Infant wide-field fundus photograph
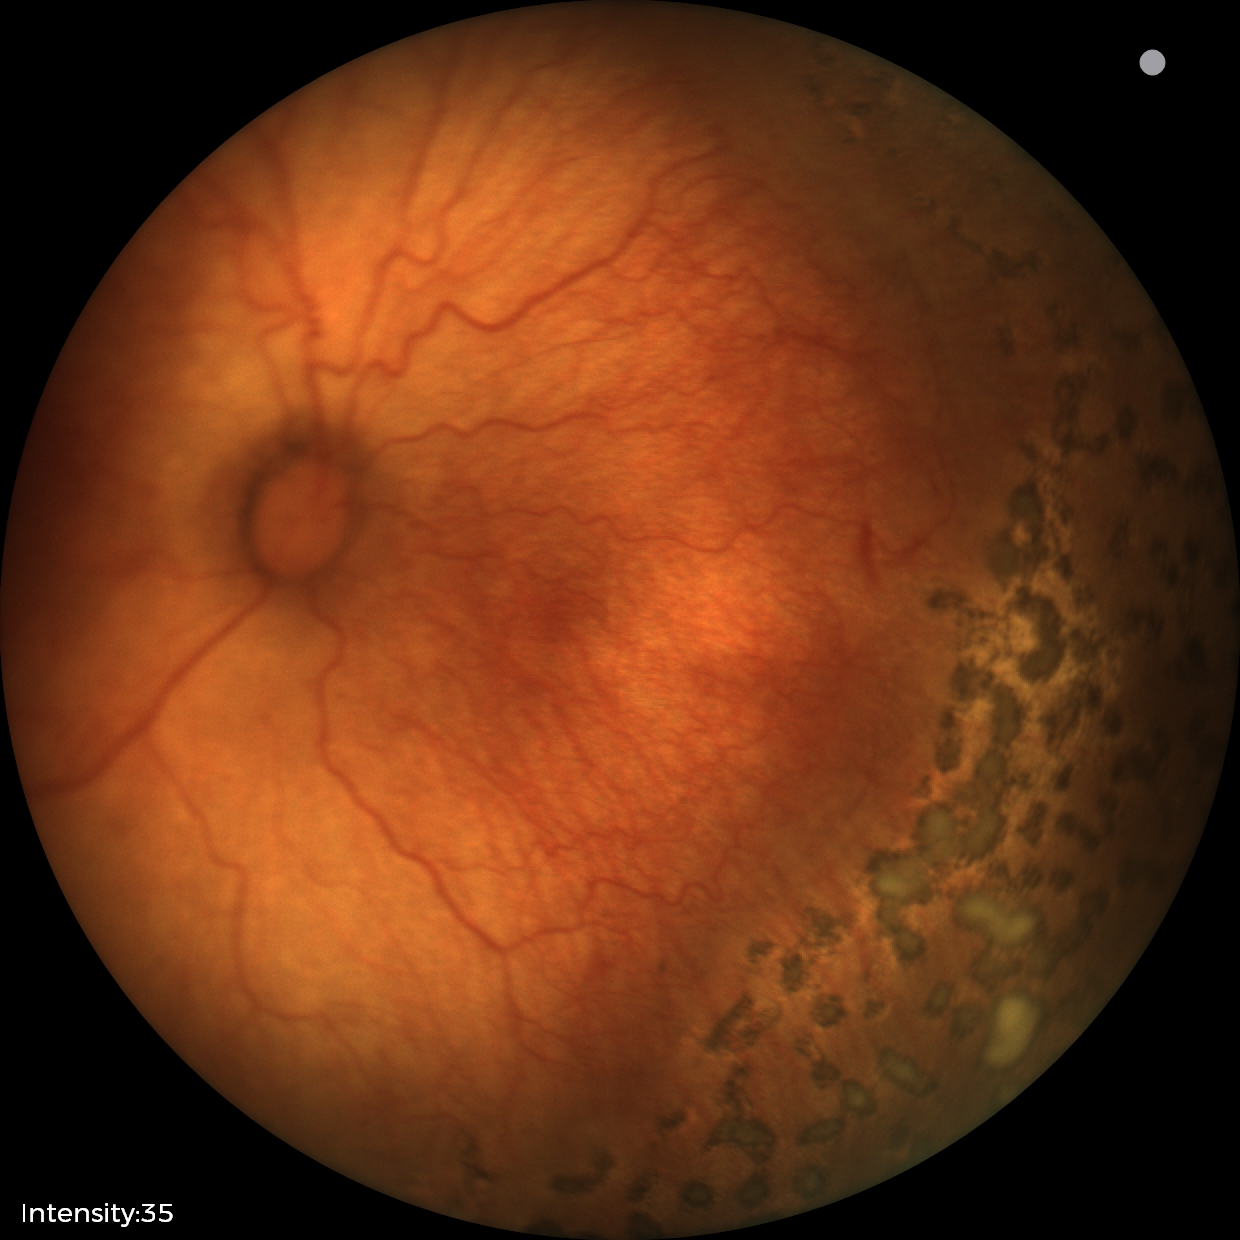
With plus disease.
Diagnosis from this screening exam: ROP stage 1.